2228x1652. Posterior pole field covering the optic disc and macula. Dilated-pupil acquisition — 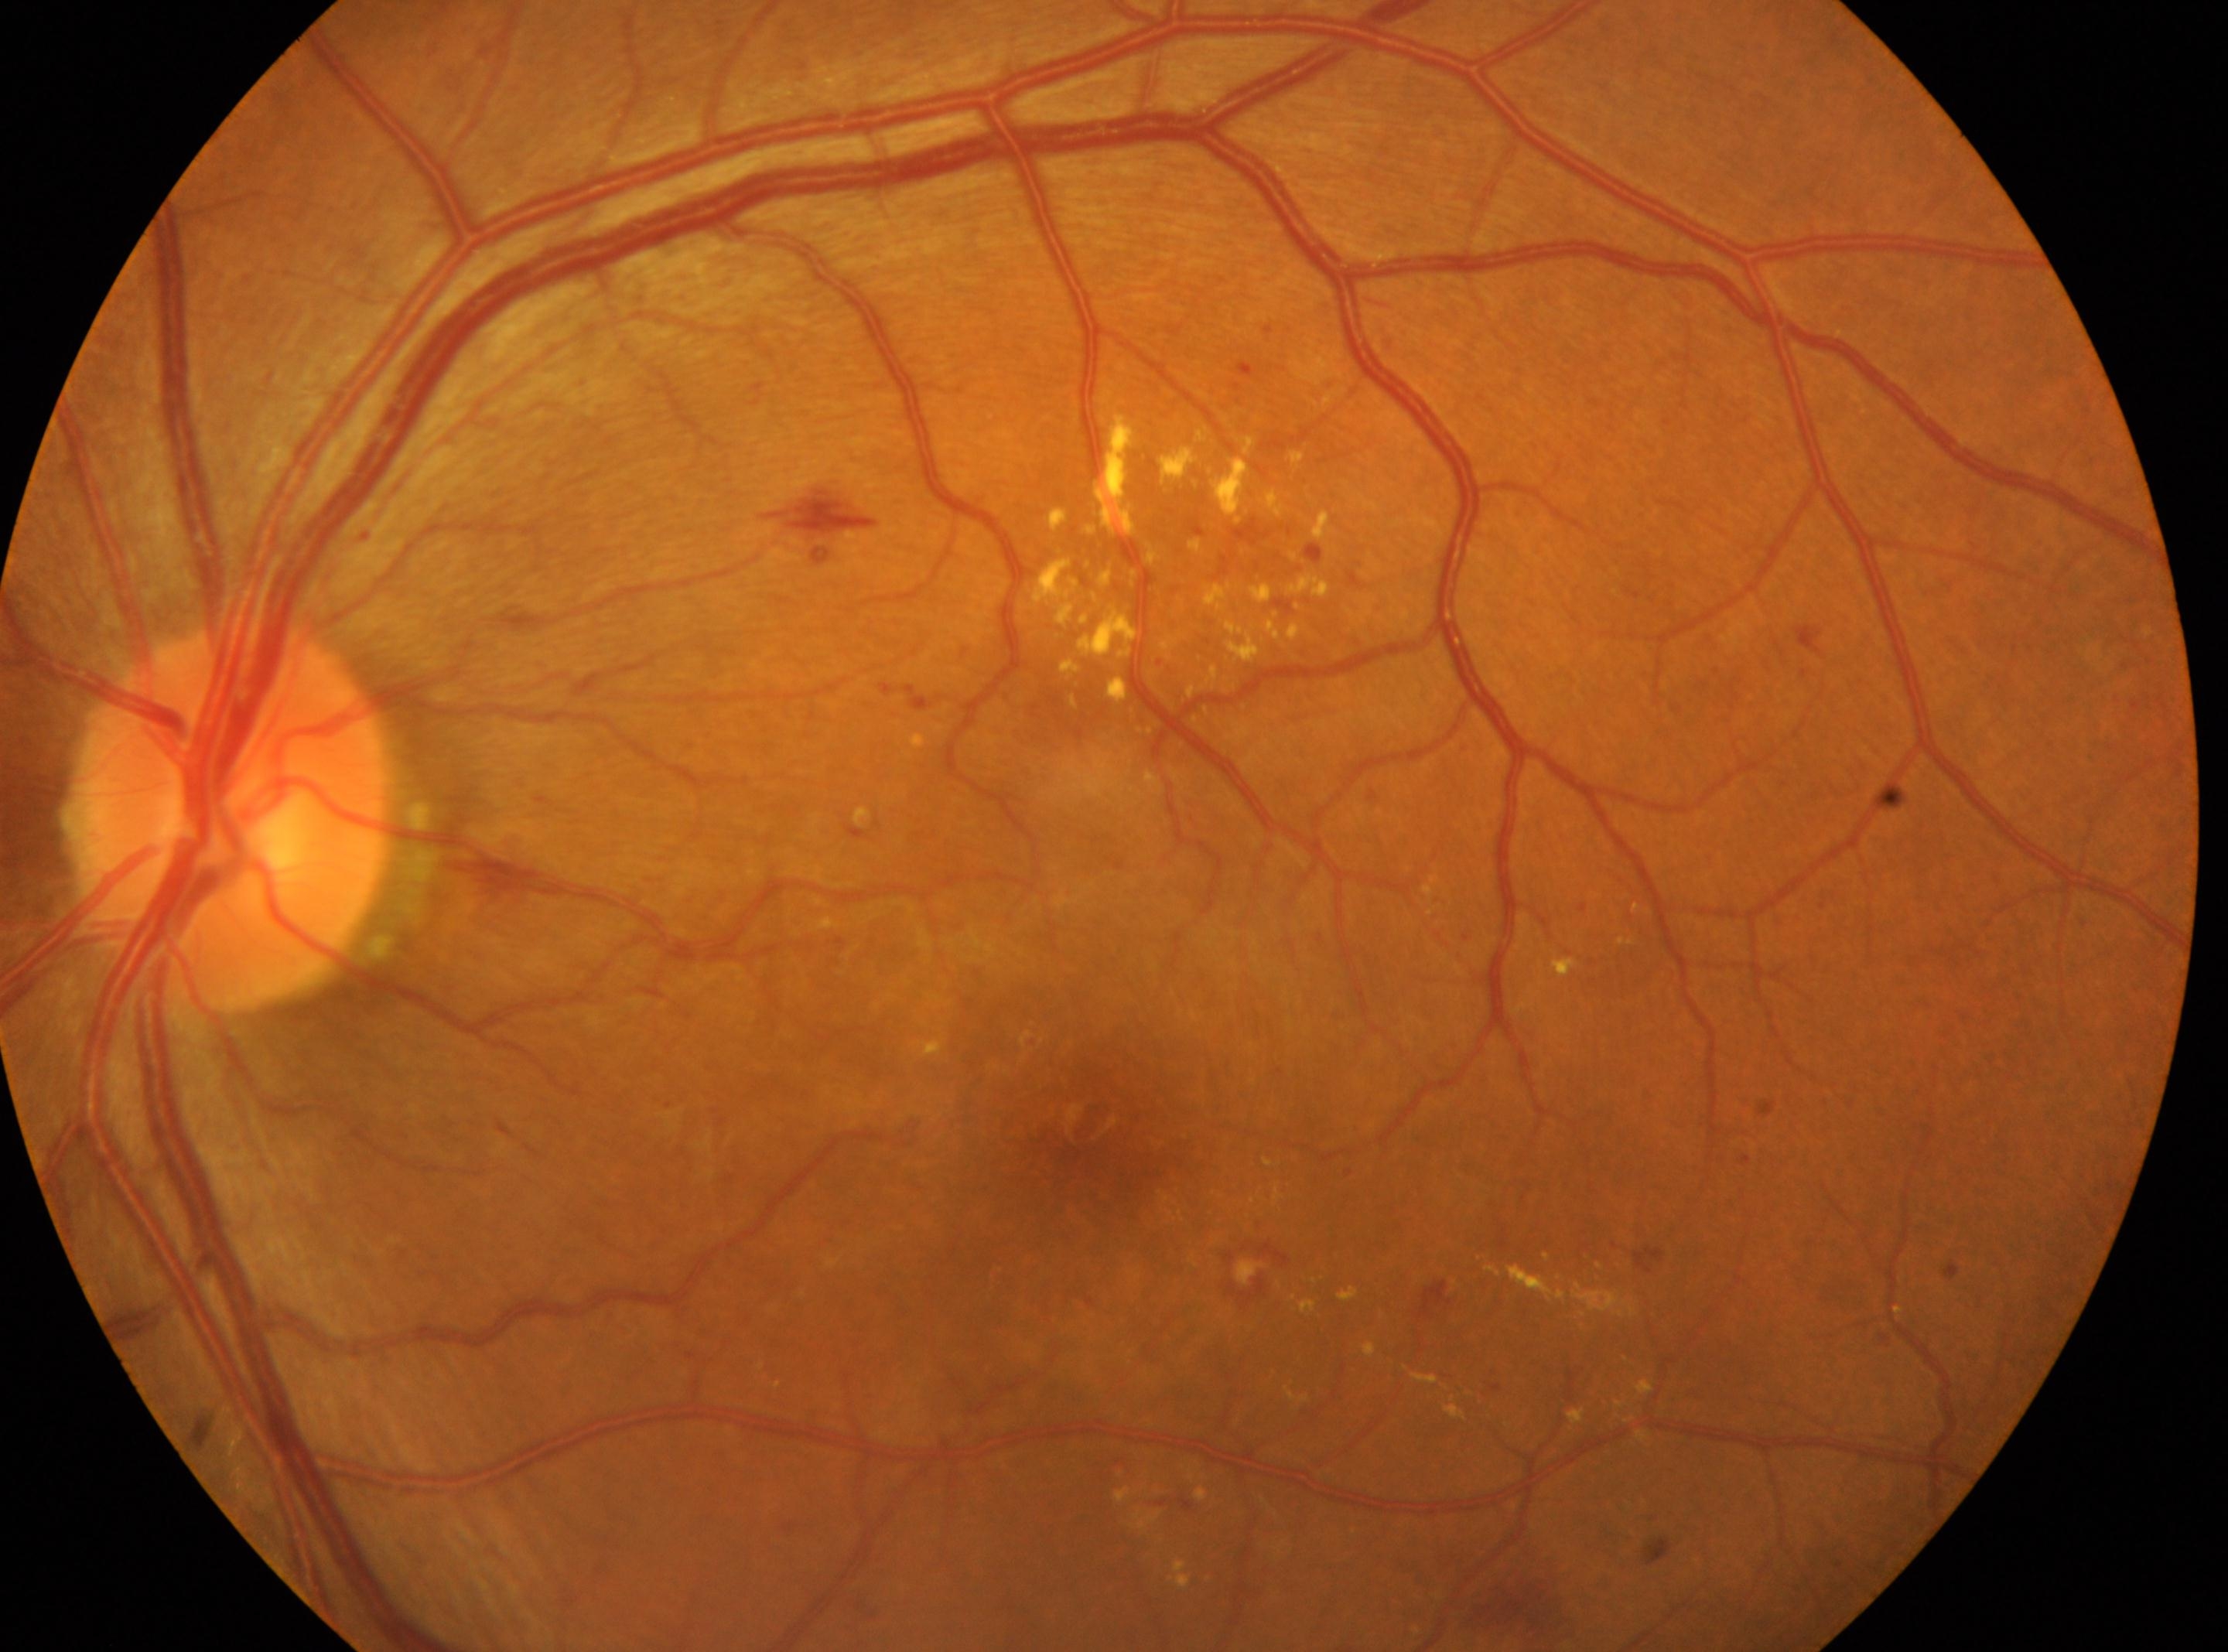
The macular center is at 1082px, 1135px.
DR stage: 2/4.
Disc center located at 227px, 815px.
Imaged eye: left.